Macula at the center of the field; 1932 by 1932 pixels:
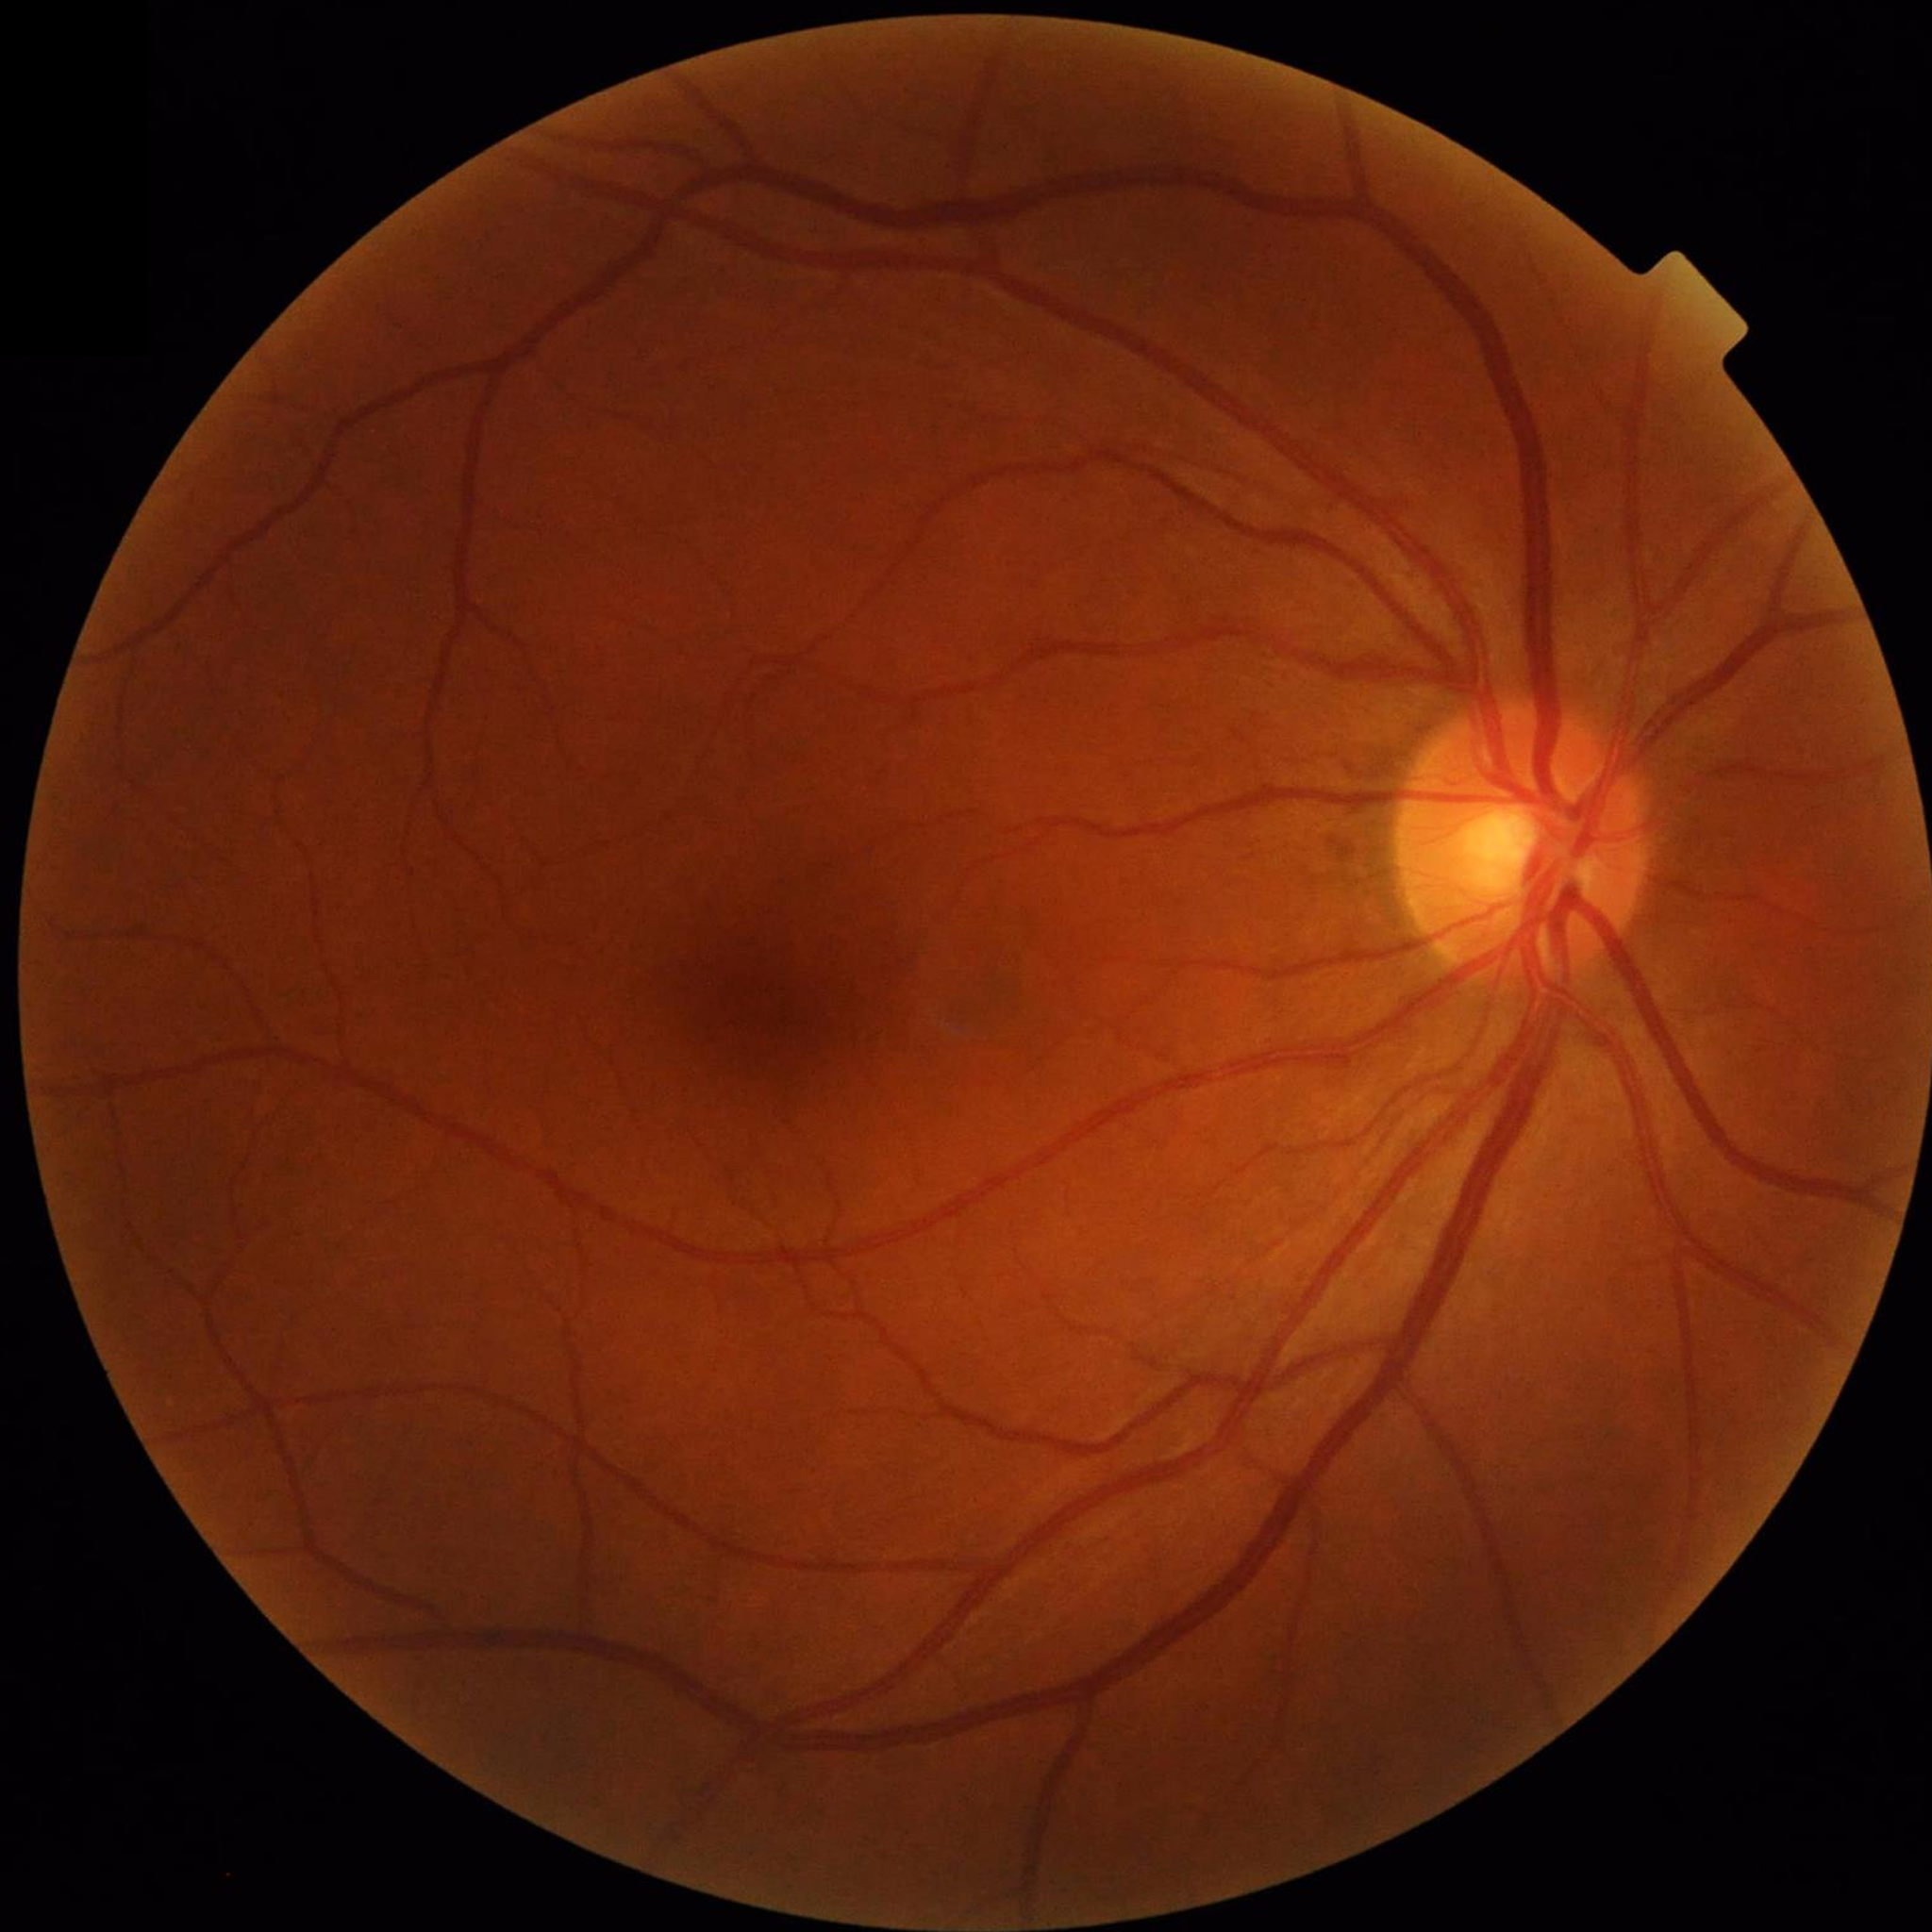
From a control without AMD, diabetic retinopathy, or glaucoma.